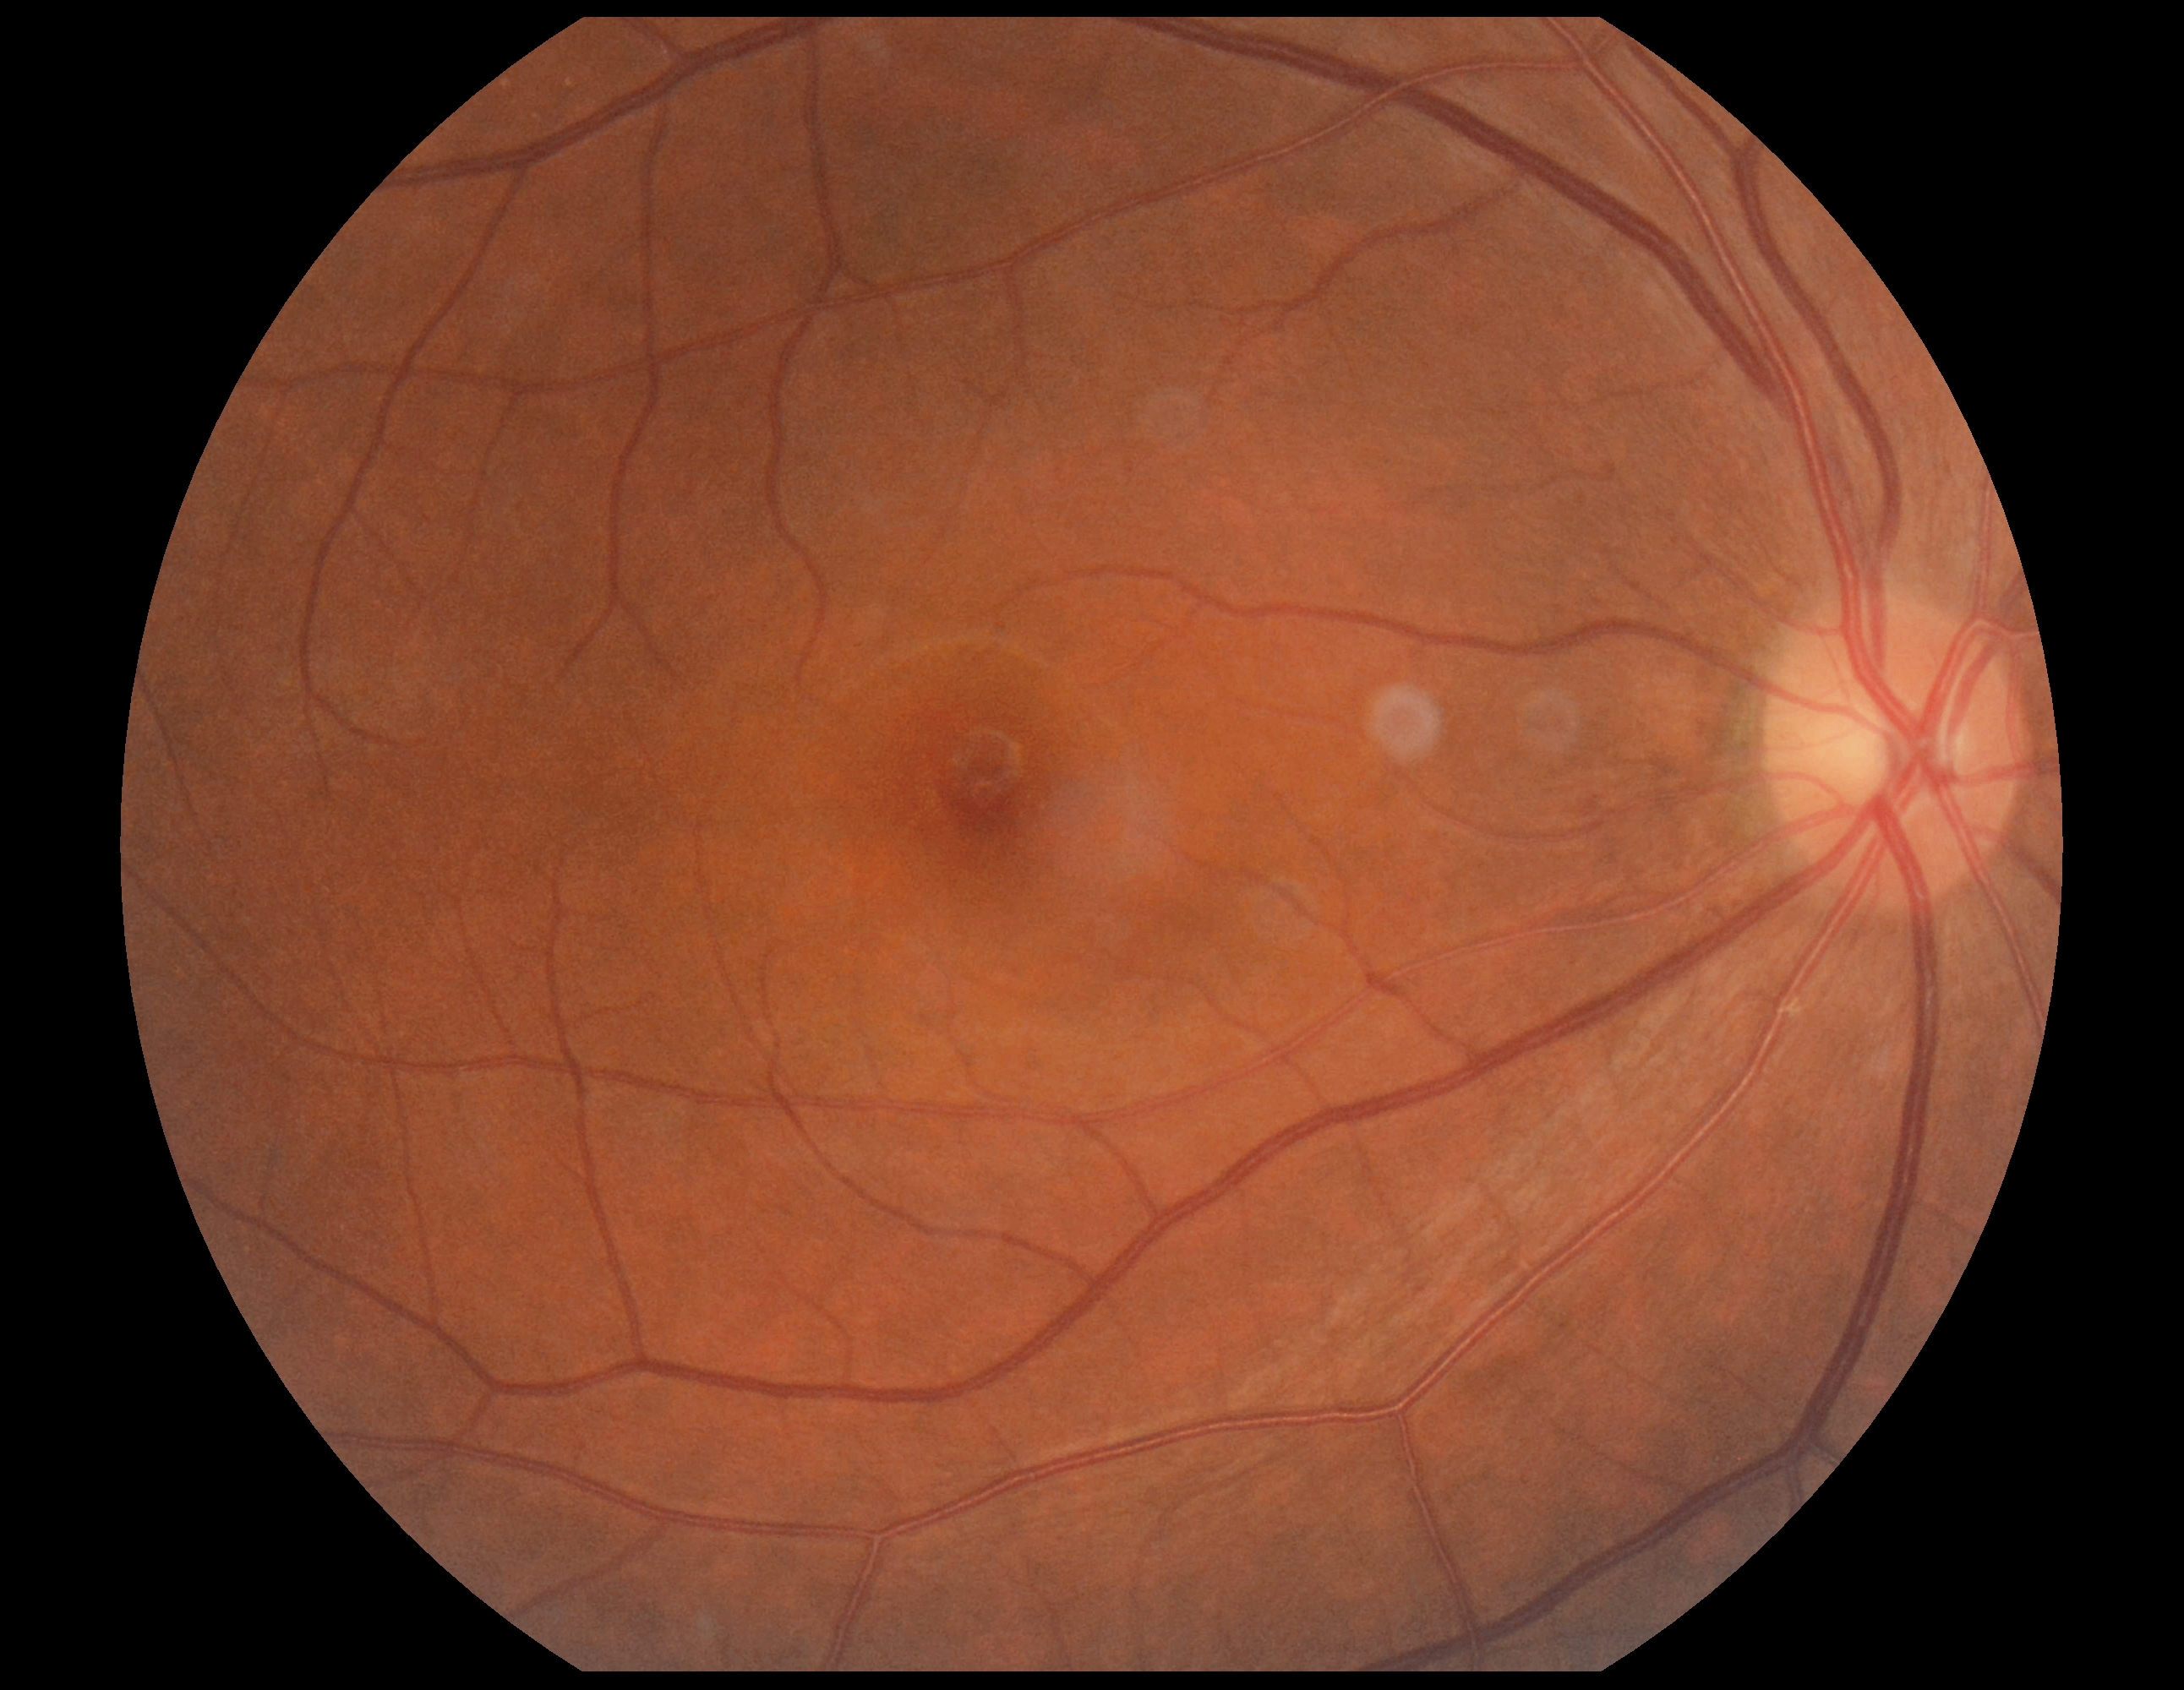
diabetic retinopathy = grade 0.